Phoenix ICON wide-field infant fundus image · 100° field of view (Phoenix ICON): 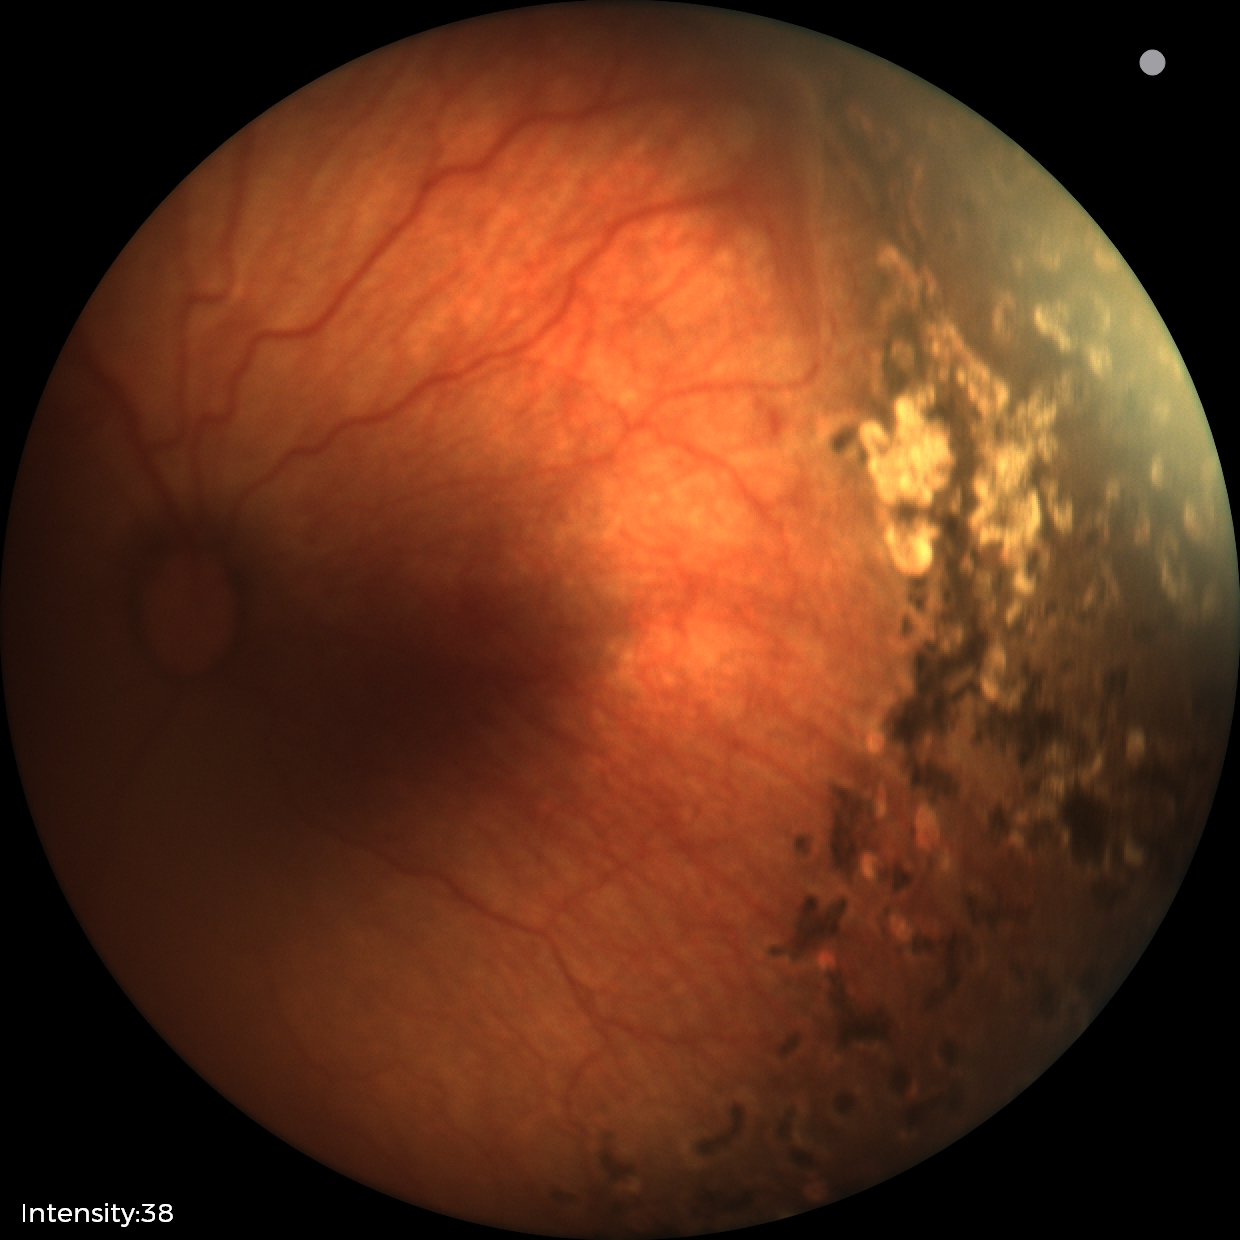 Q: What was the screening finding?
A: status post retinopathy of prematurity — retinal appearance after treated retinopathy of prematurity
Q: Is plus disease present?
A: no plus disease